FOV: 45 degrees; no pharmacologic dilation; color fundus image; 848 x 848 pixels — 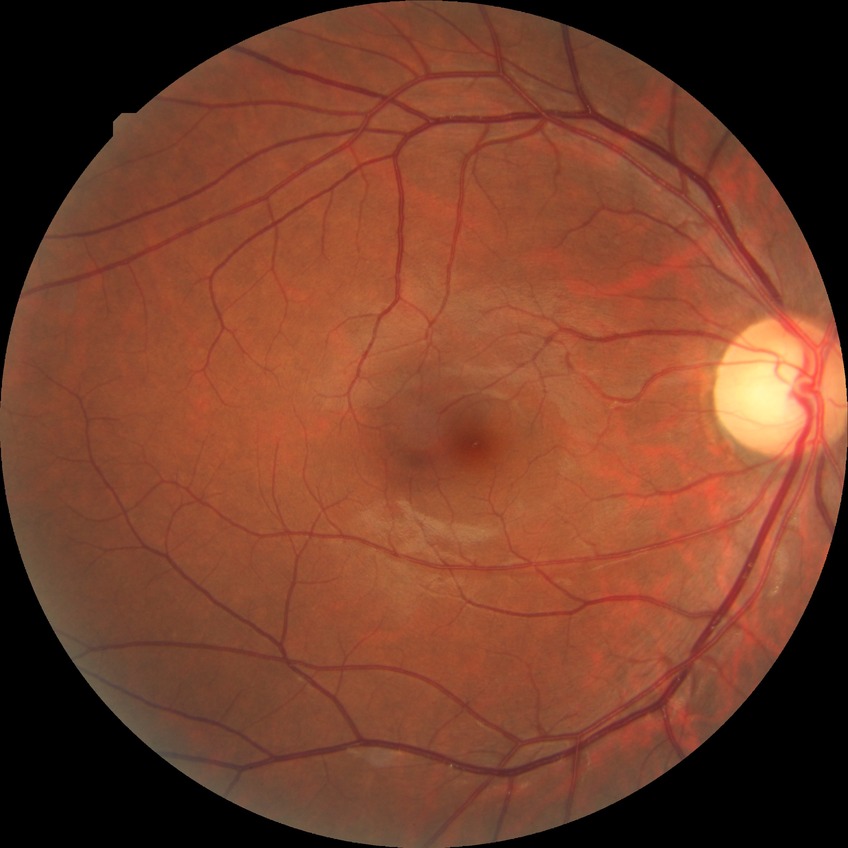
Diabetic retinopathy (DR): no diabetic retinopathy (NDR).